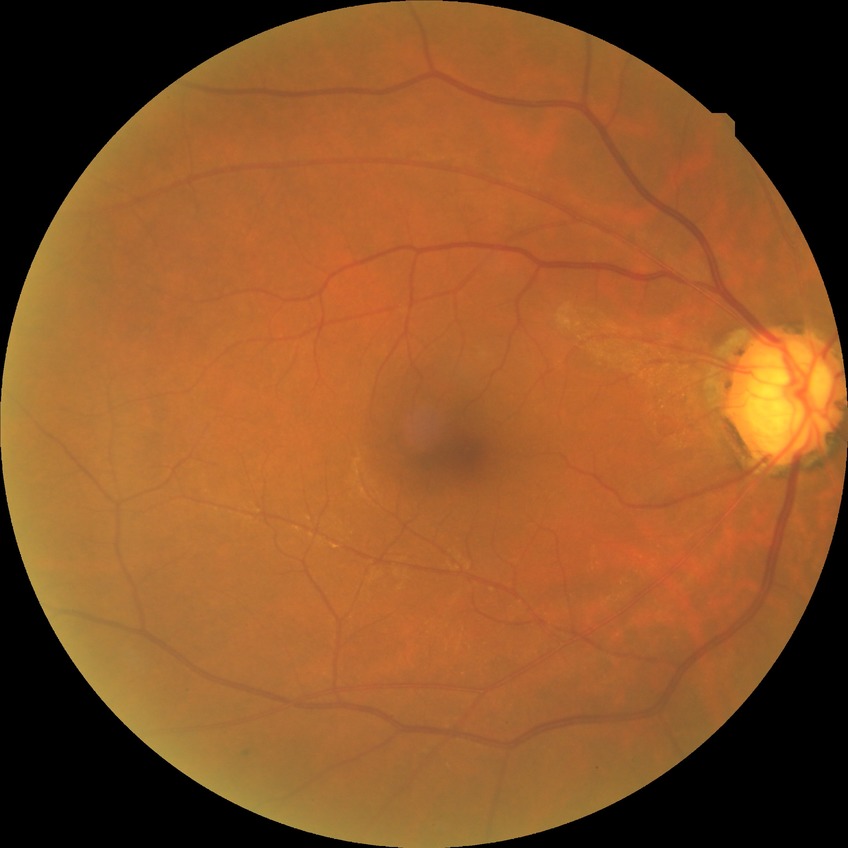
modified Davis grading = no diabetic retinopathy.